Wide-field fundus photograph of an infant: 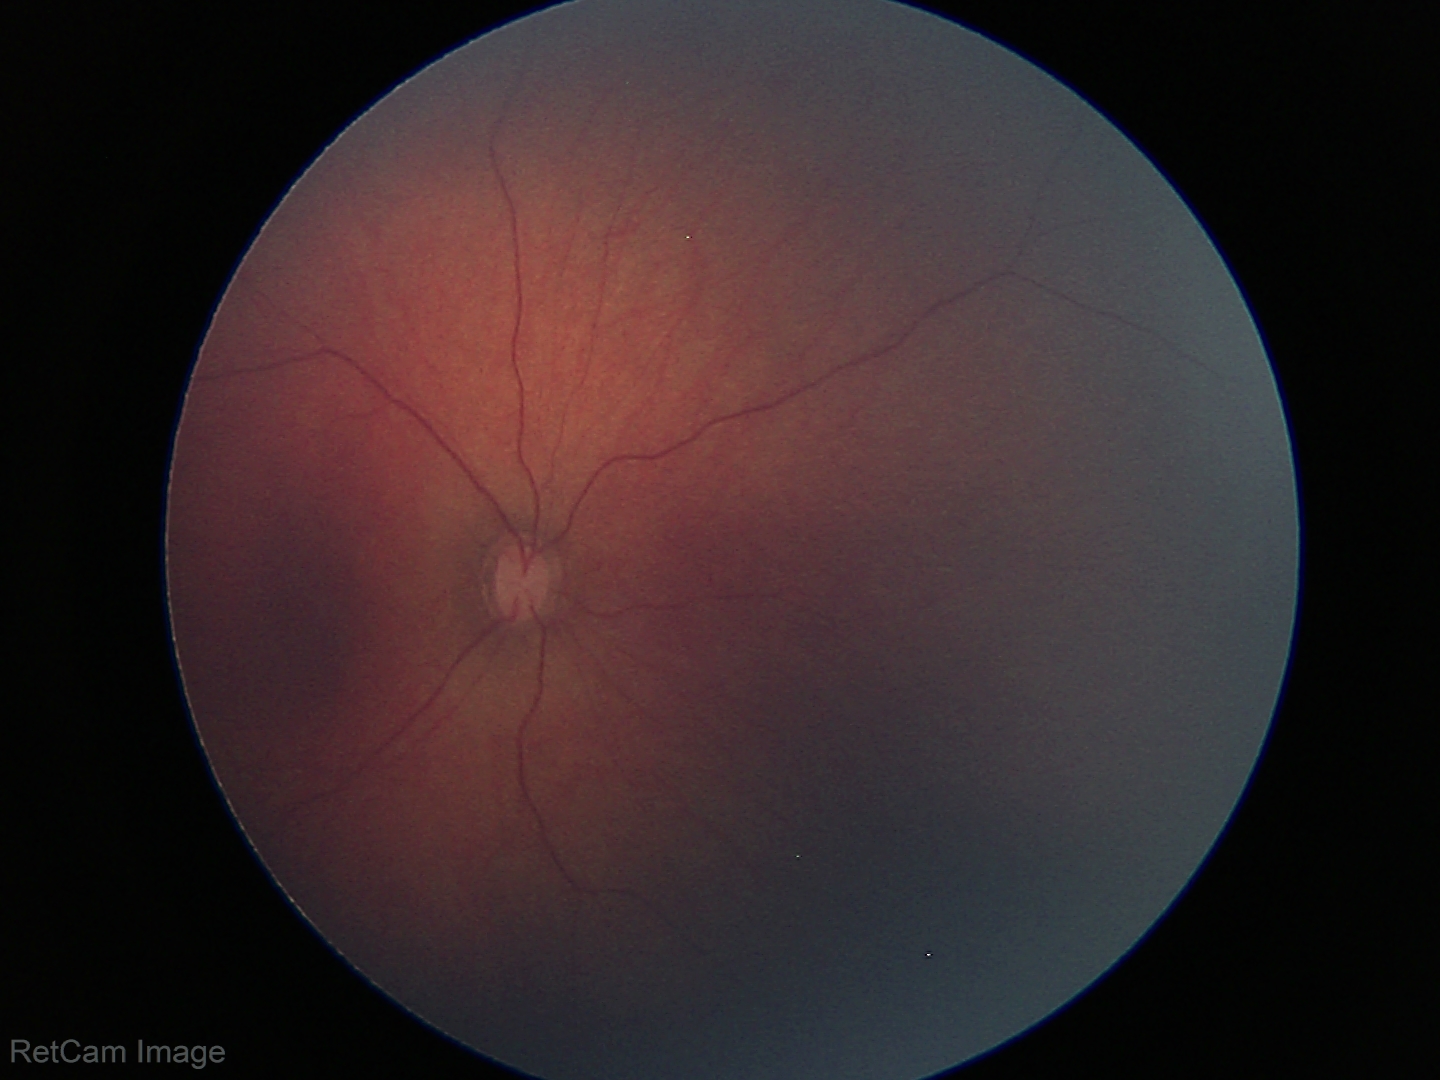

Screening examination diagnosed as physiological.